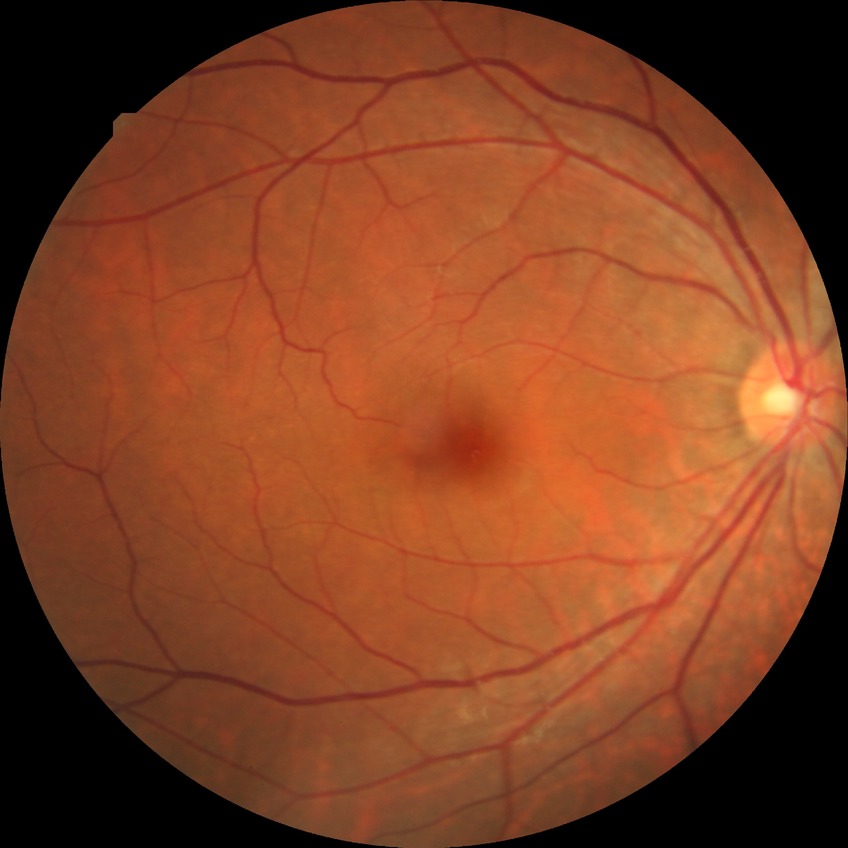

DR impression=no DR findings; DR=NDR.